Fundus photograph cropped around the optic nerve head.
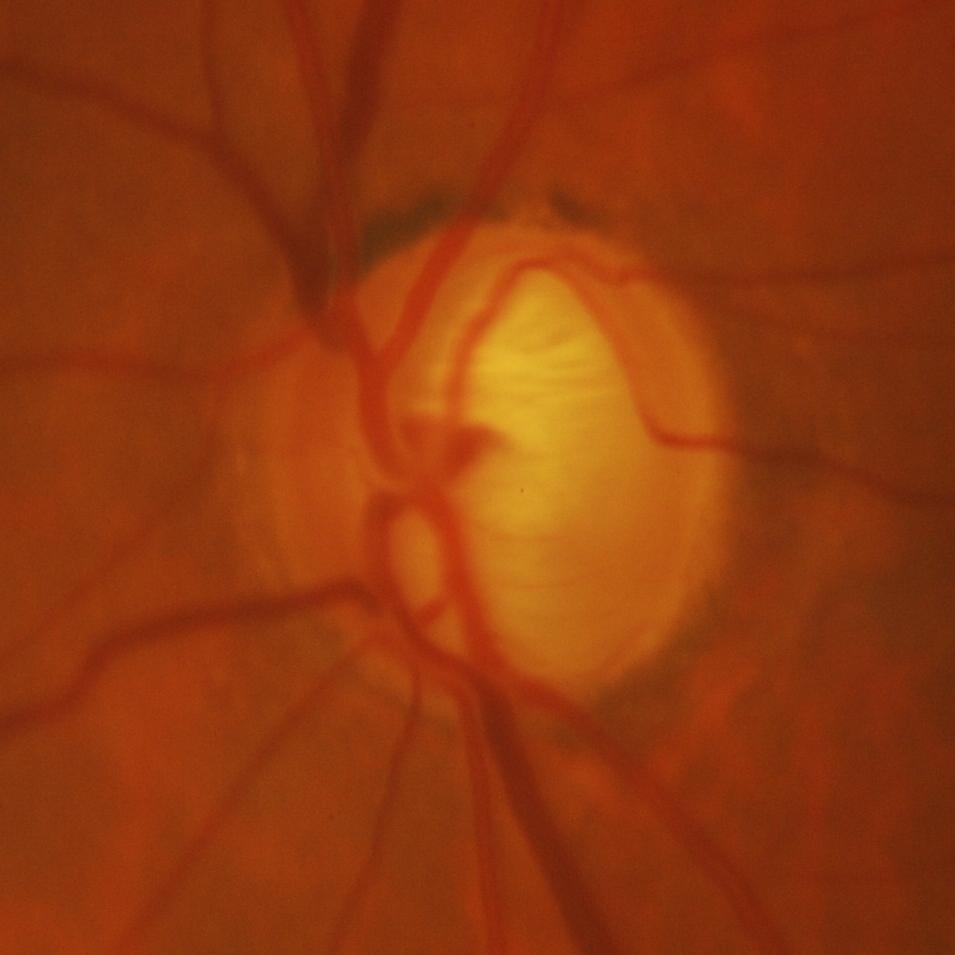
Q: What is the glaucoma diagnosis?
A: Yes — glaucomatous findings.